45° field of view
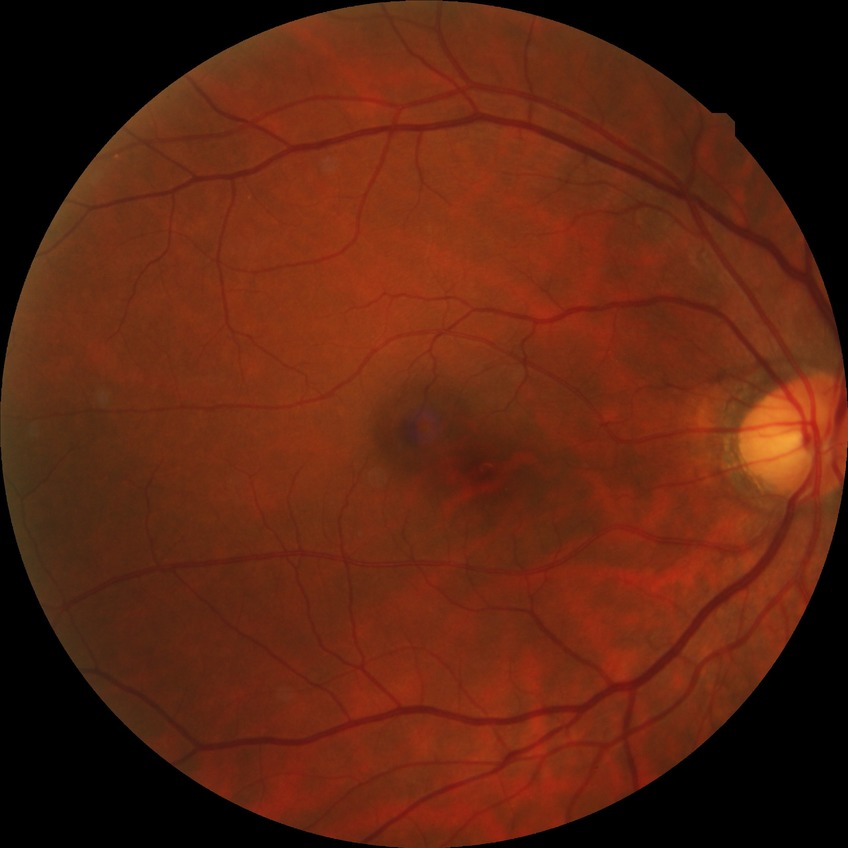

Findings:
– diabetic retinopathy (DR) — NDR (no diabetic retinopathy)